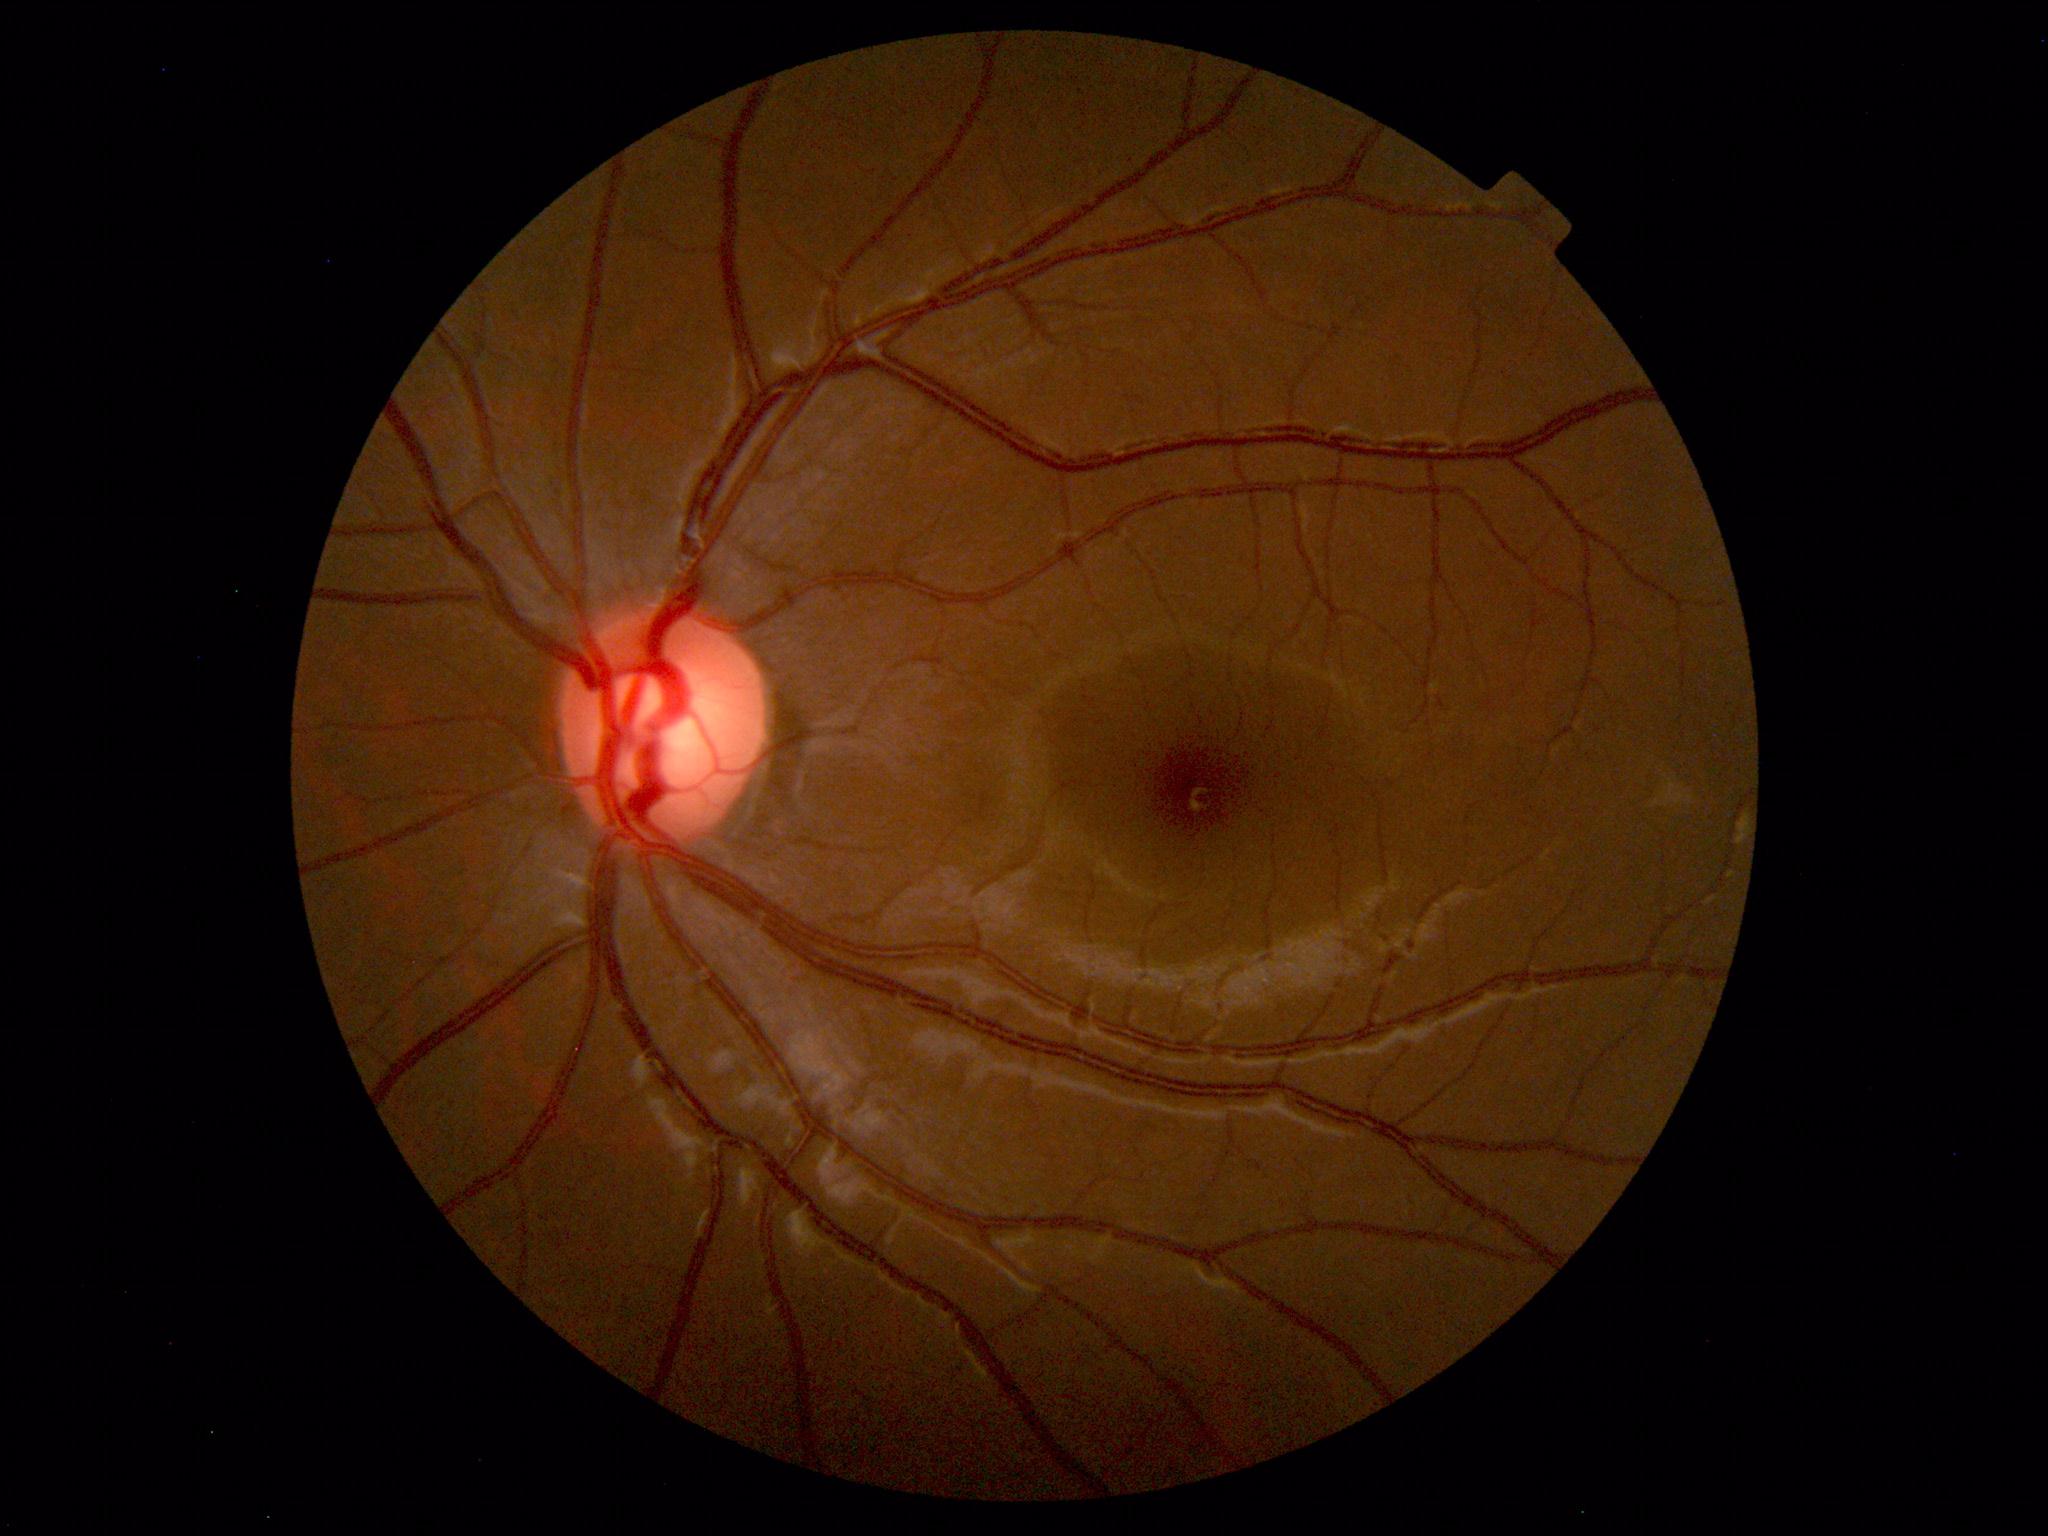 Findings: none. Normal fundus.